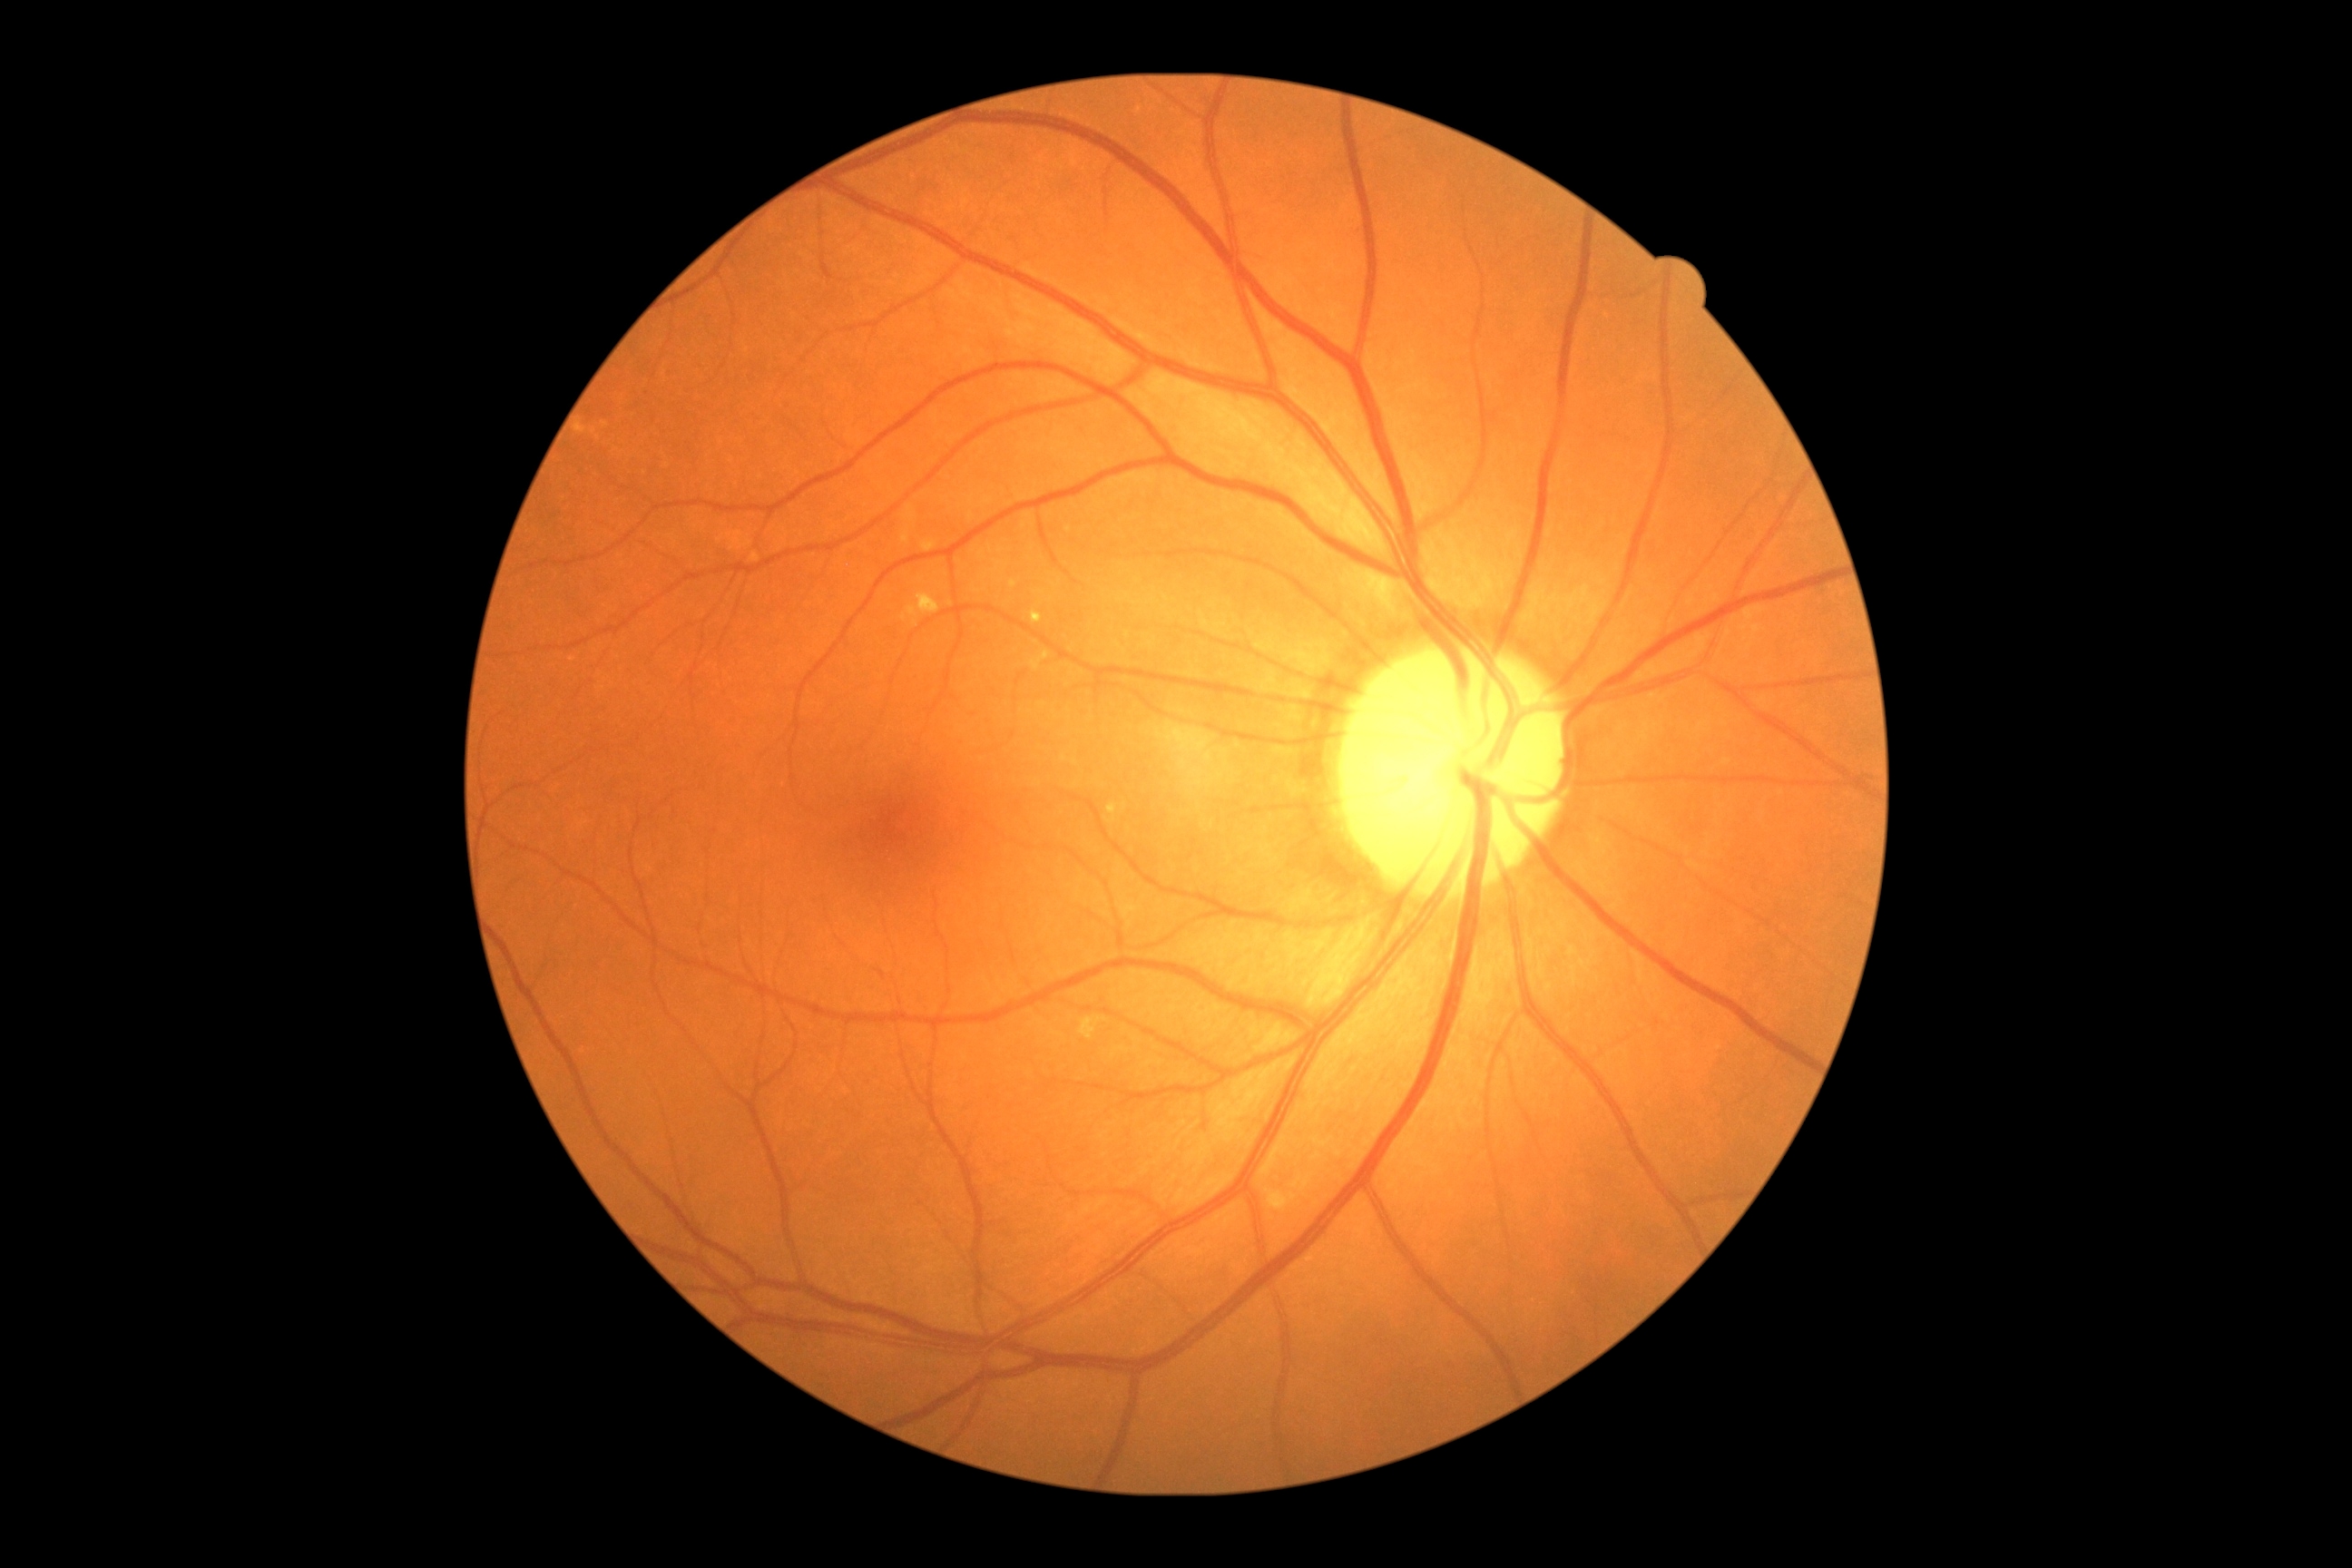

Diabetic retinopathy severity is no apparent retinopathy (grade 0) — no visible signs of diabetic retinopathy.